1932 x 1932 pixels; fundus photo
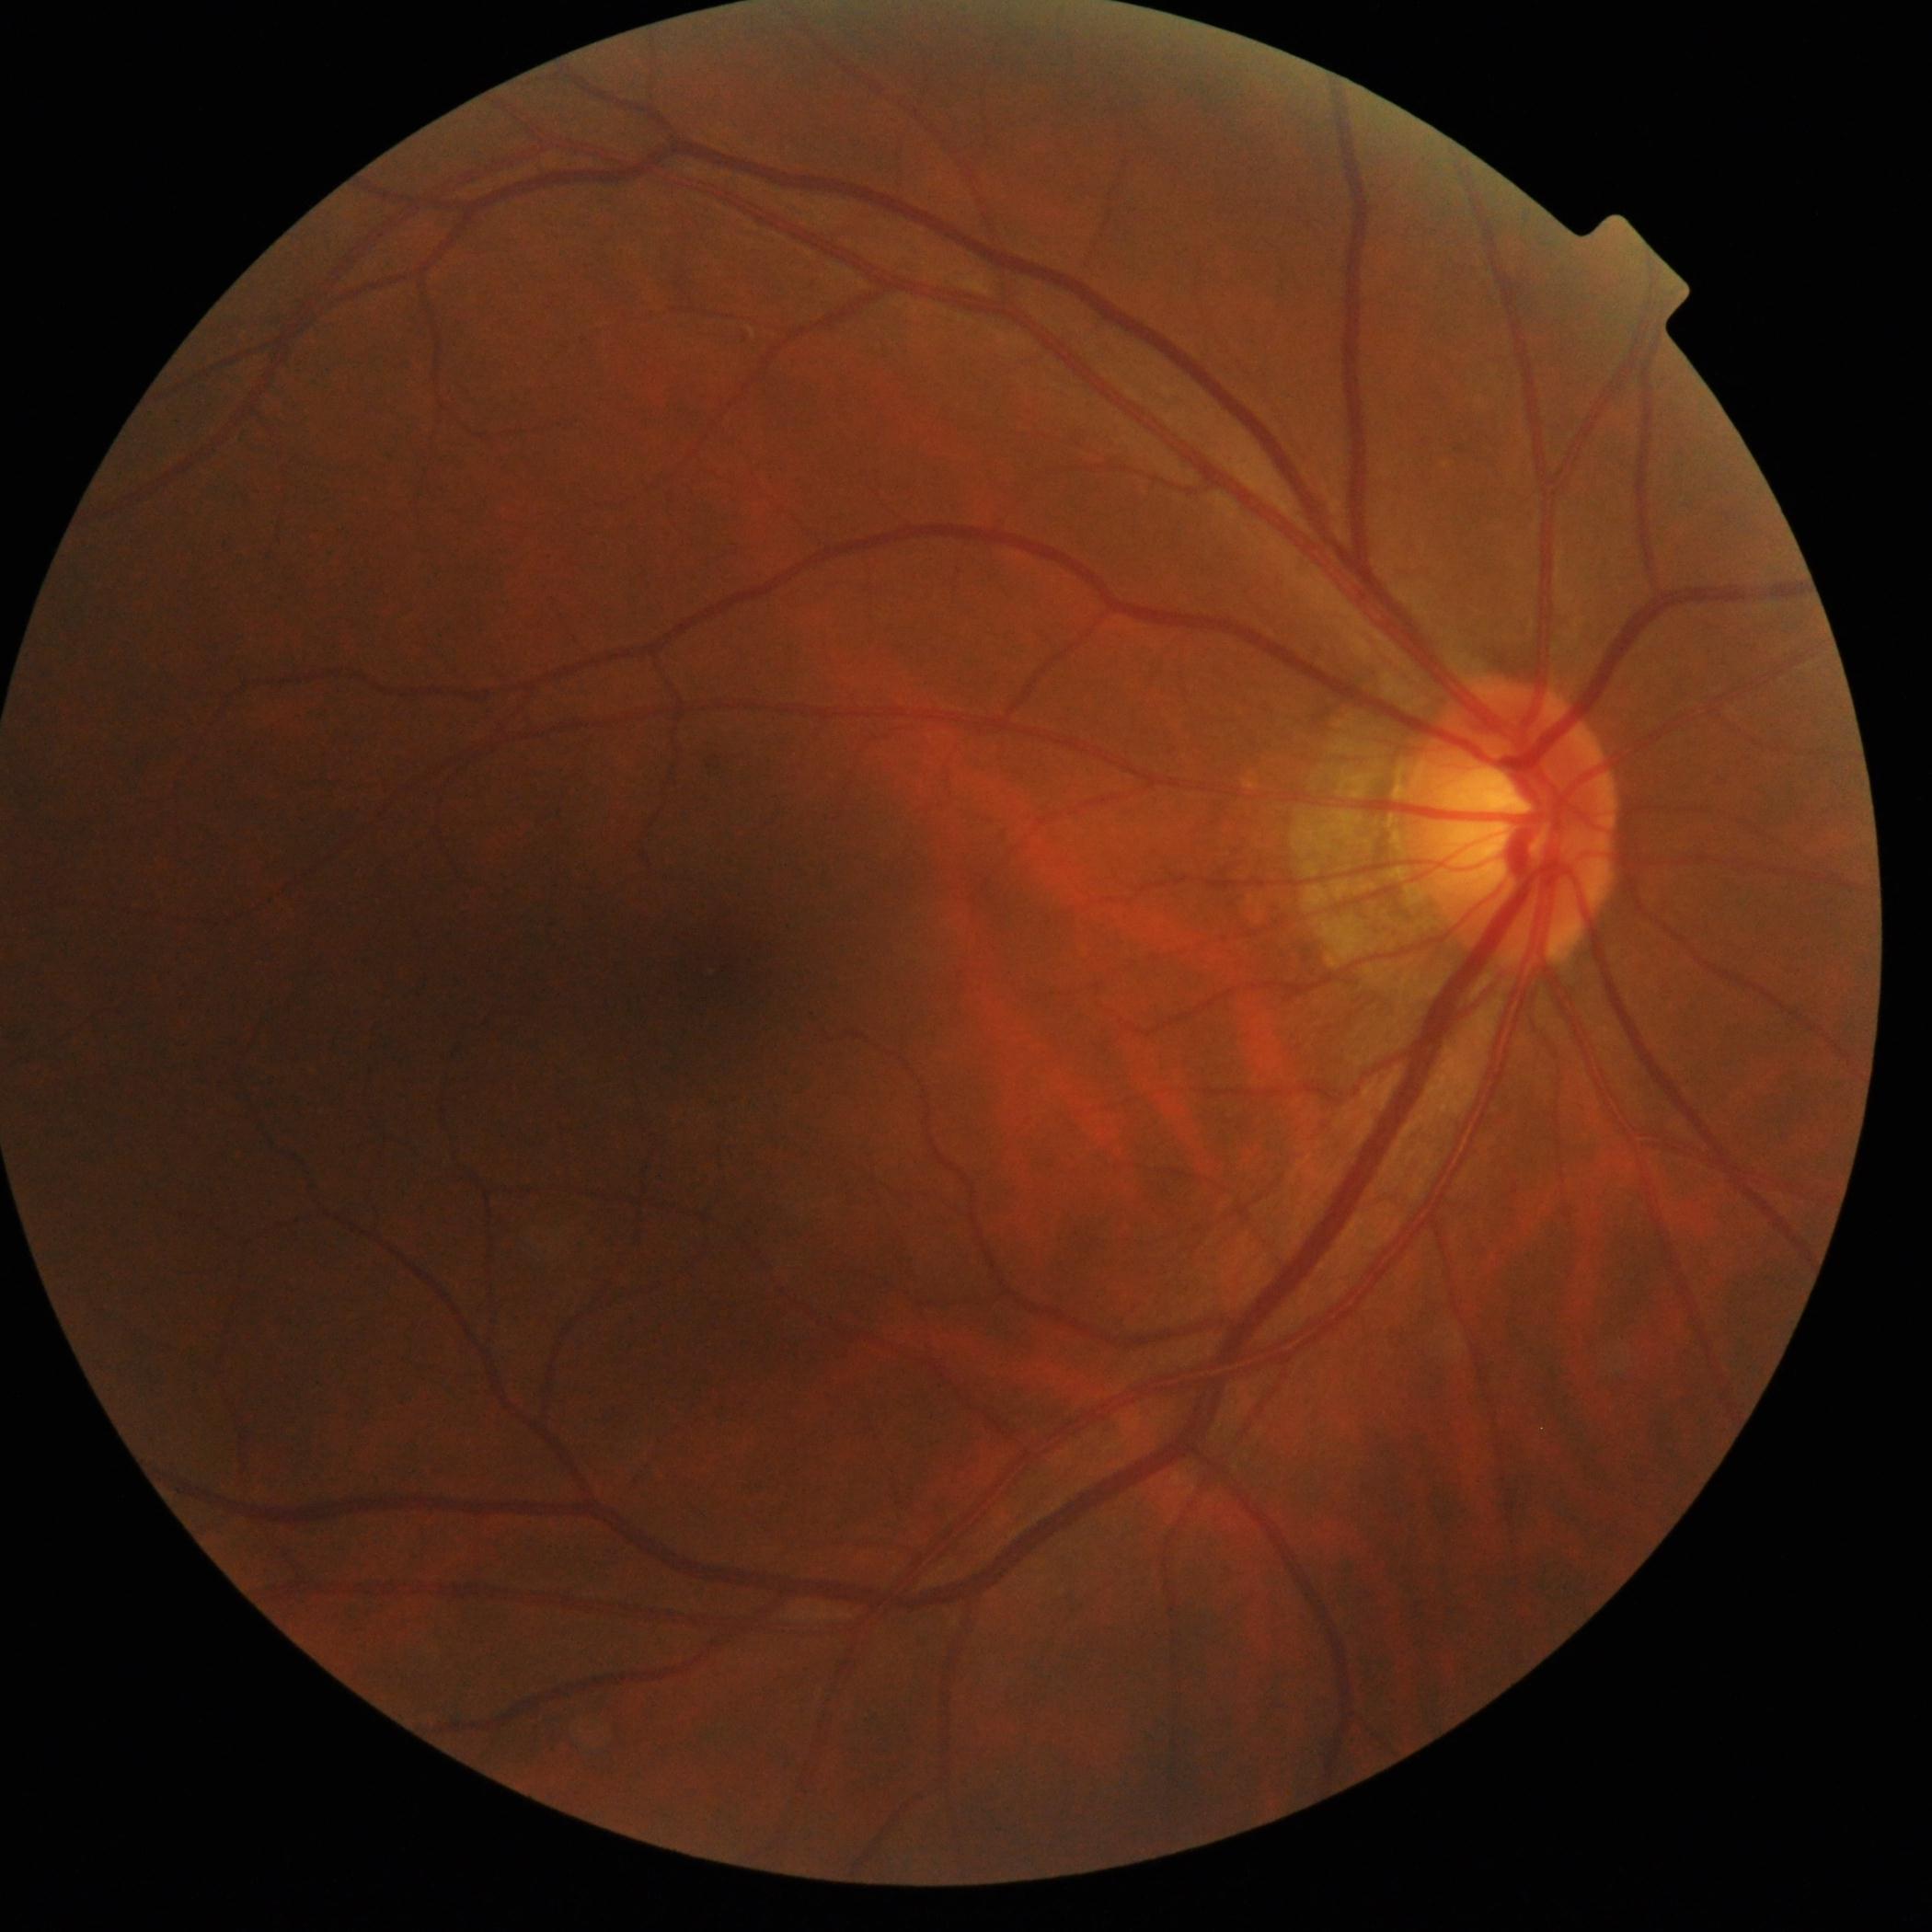 Diabetic retinopathy (DR): no apparent diabetic retinopathy (grade 0).